FOV: 45 degrees
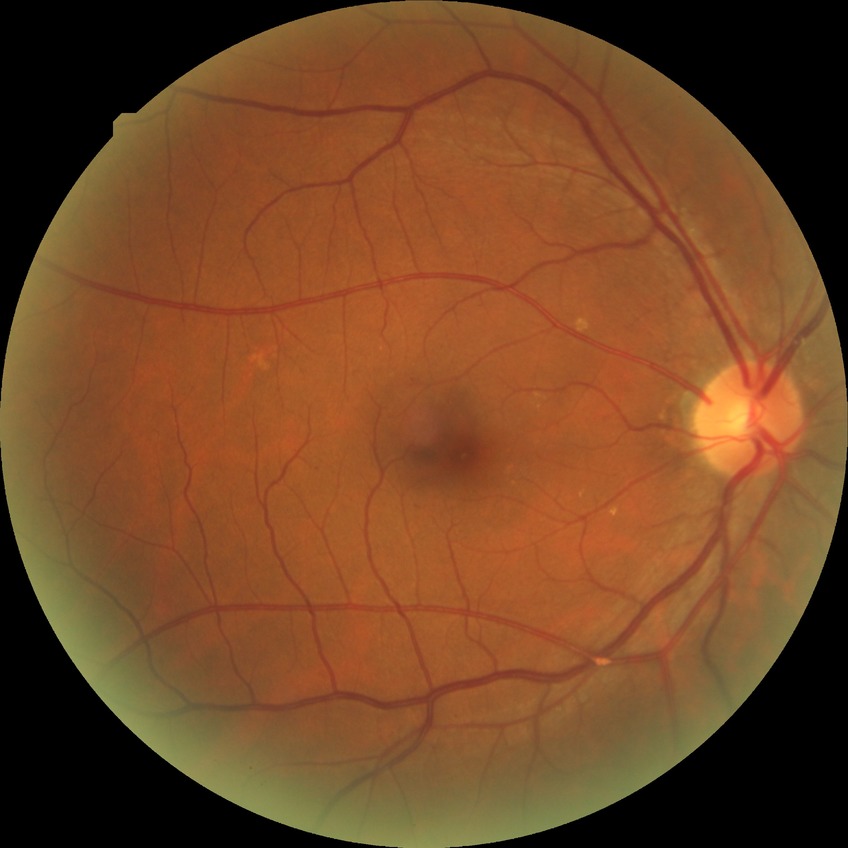

diabetic retinopathy (DR): NDR (no diabetic retinopathy).